640 by 480 pixels. Camera: Clarity RetCam 3 (130° FOV). Infant wide-field fundus photograph:
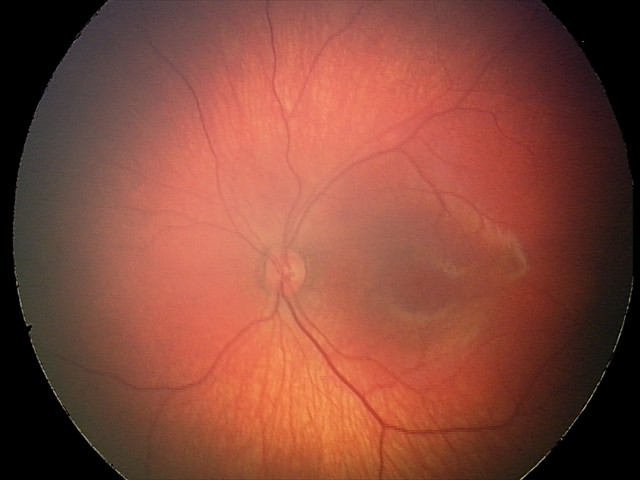

Series diagnosed as retinal hemorrhages.